Phoenix ICON wide-field infant fundus image. Acquired on the Phoenix ICON. 1240 x 1240 pixels: 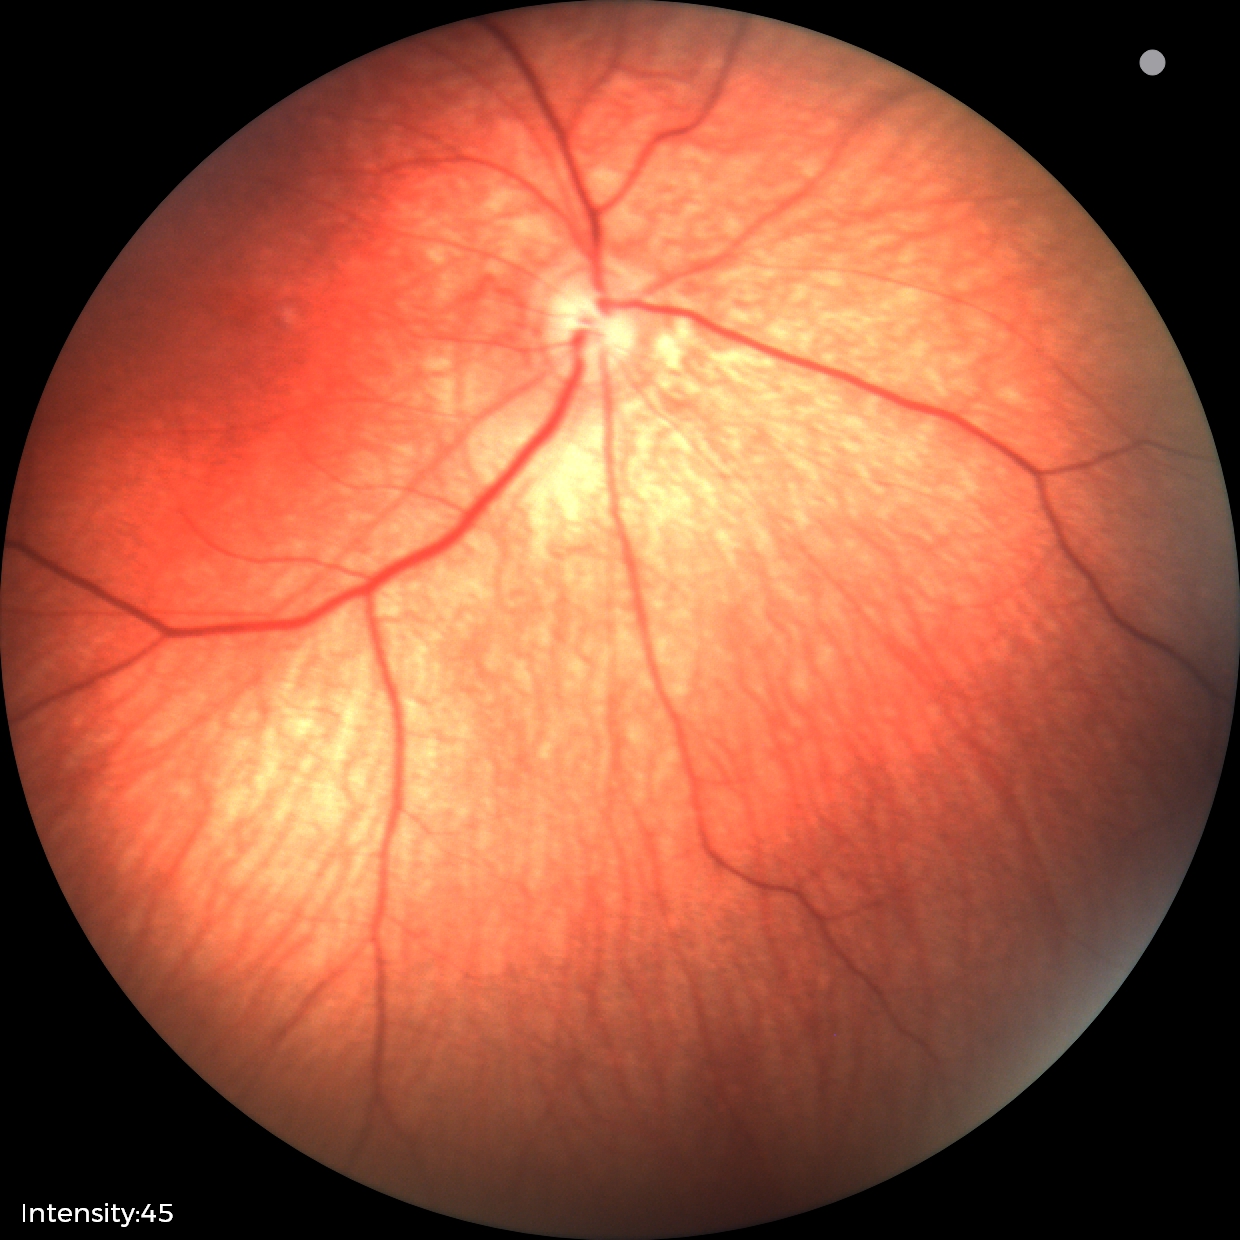
Examination with physiological retinal findings.